FOV: 45 degrees
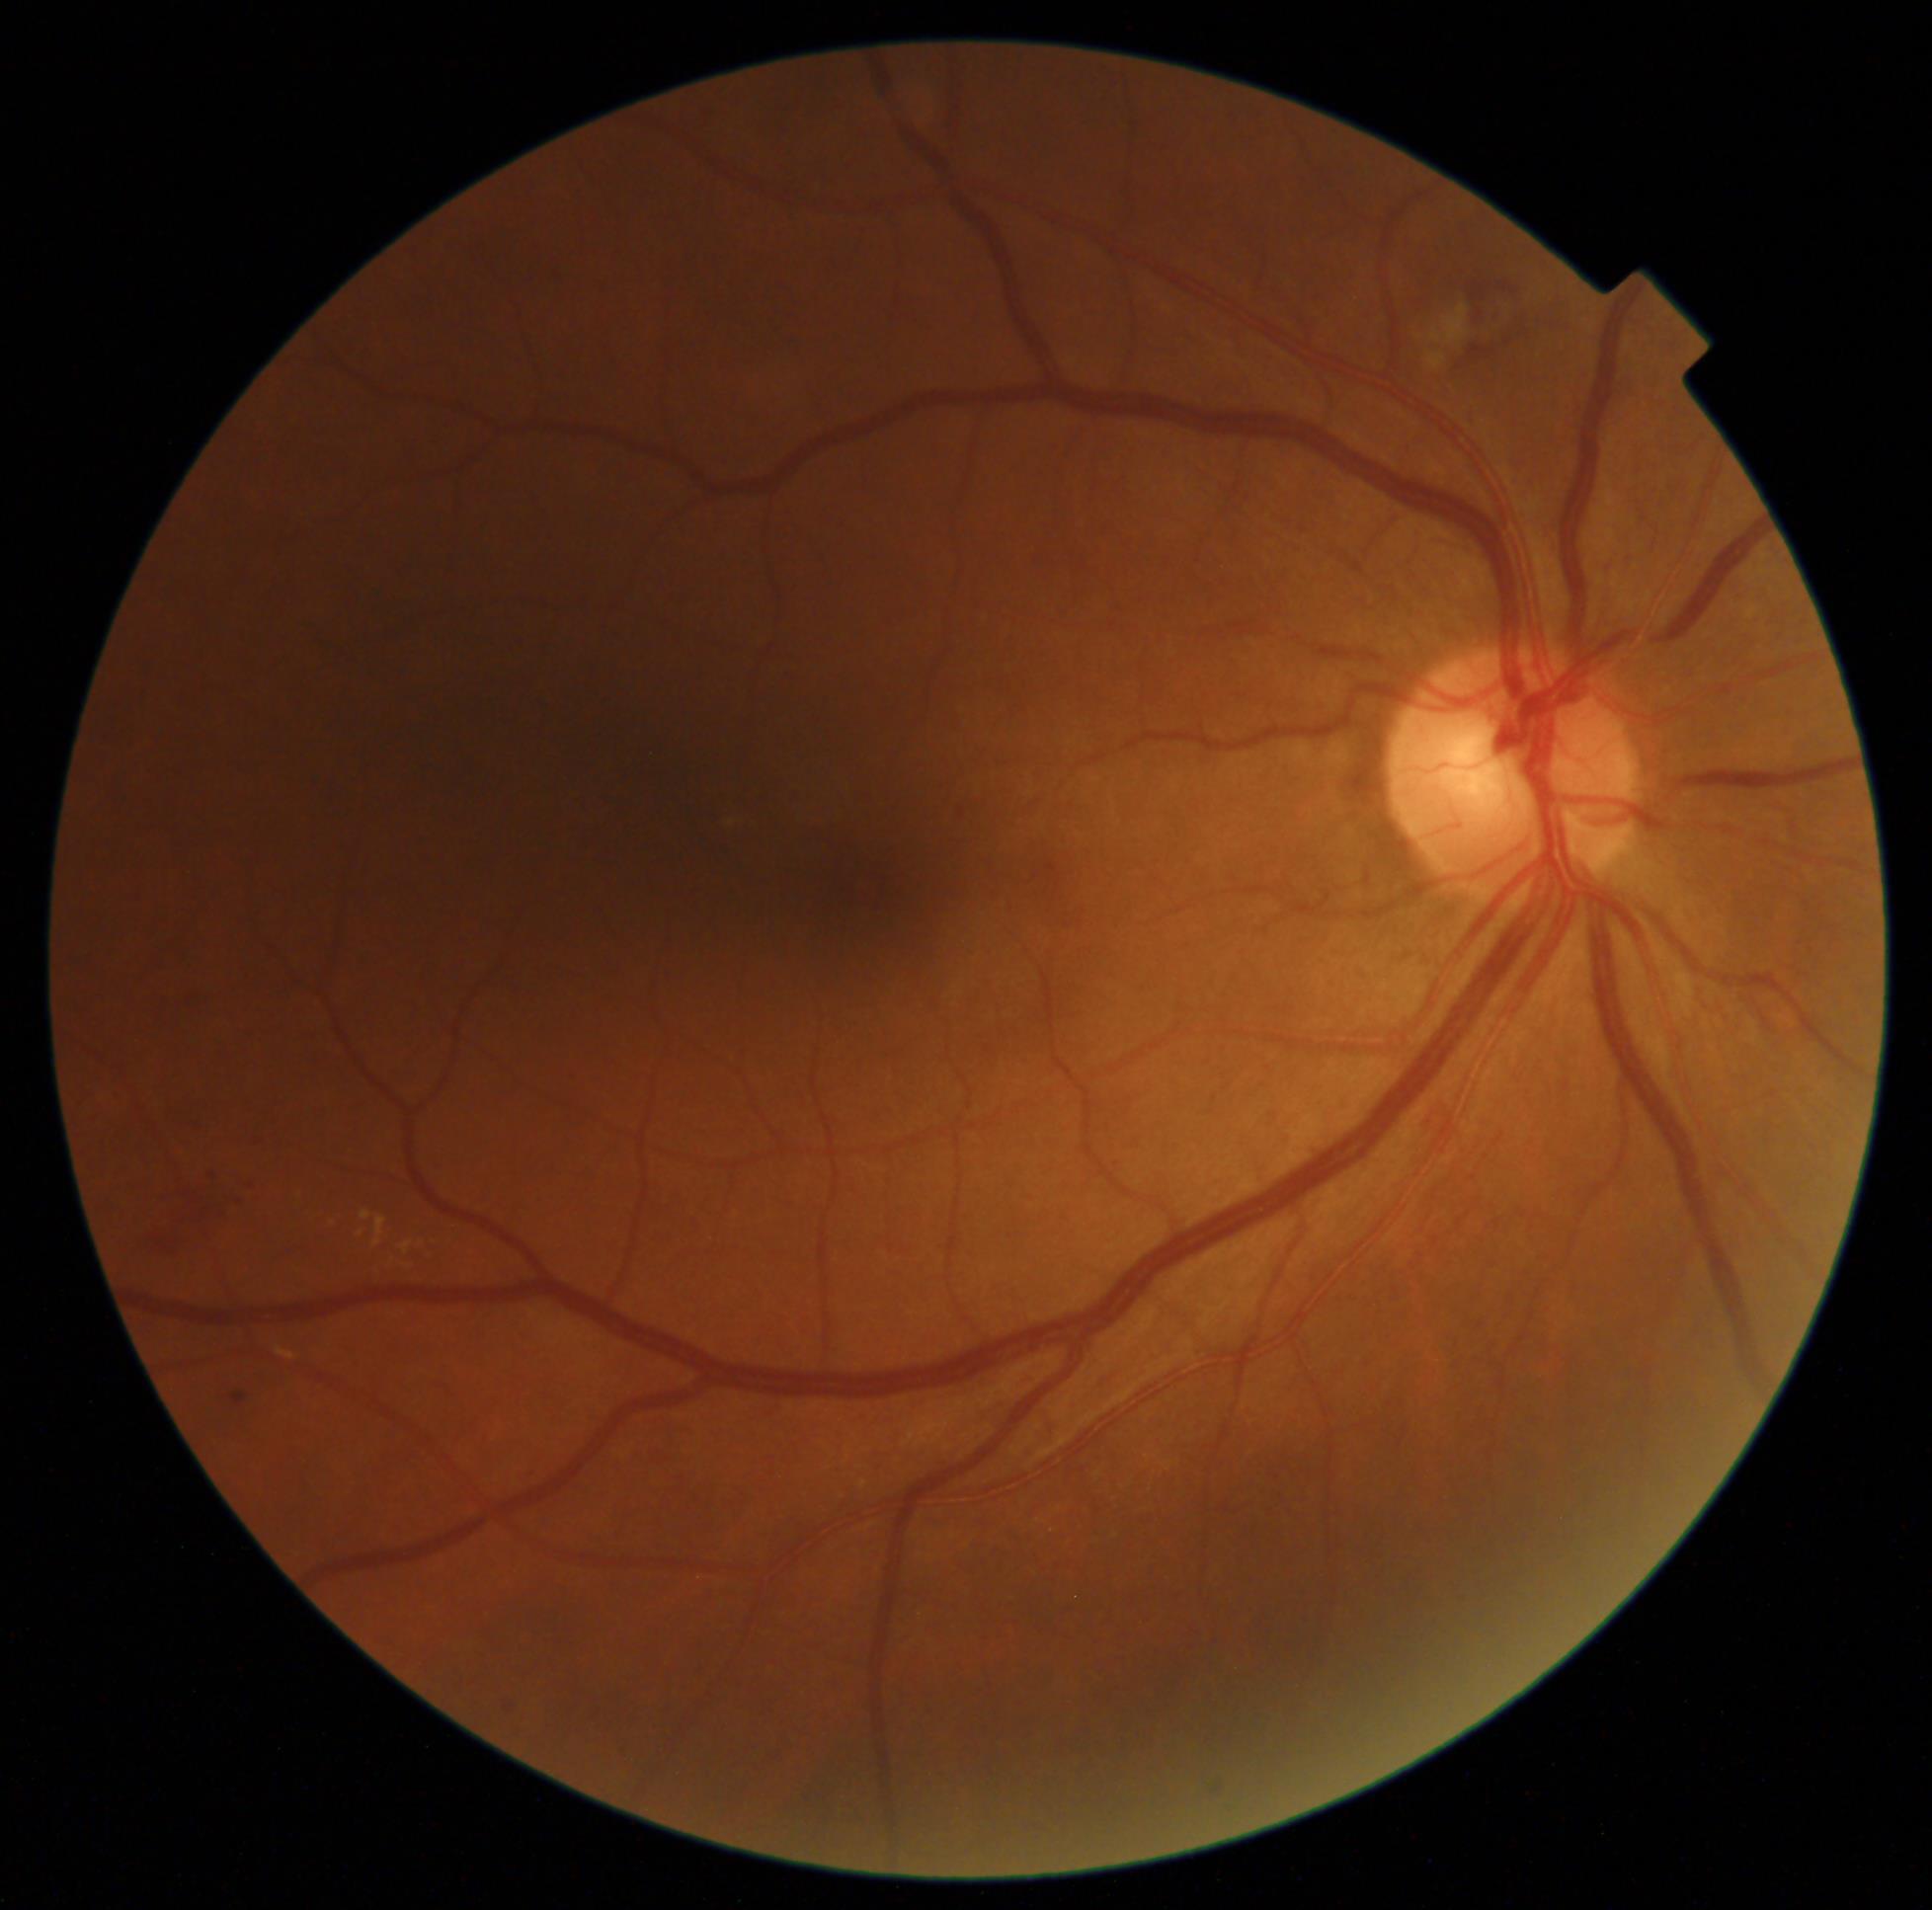 Diabetic retinopathy (DR) is 2/4.
Disease class: non-proliferative diabetic retinopathy.